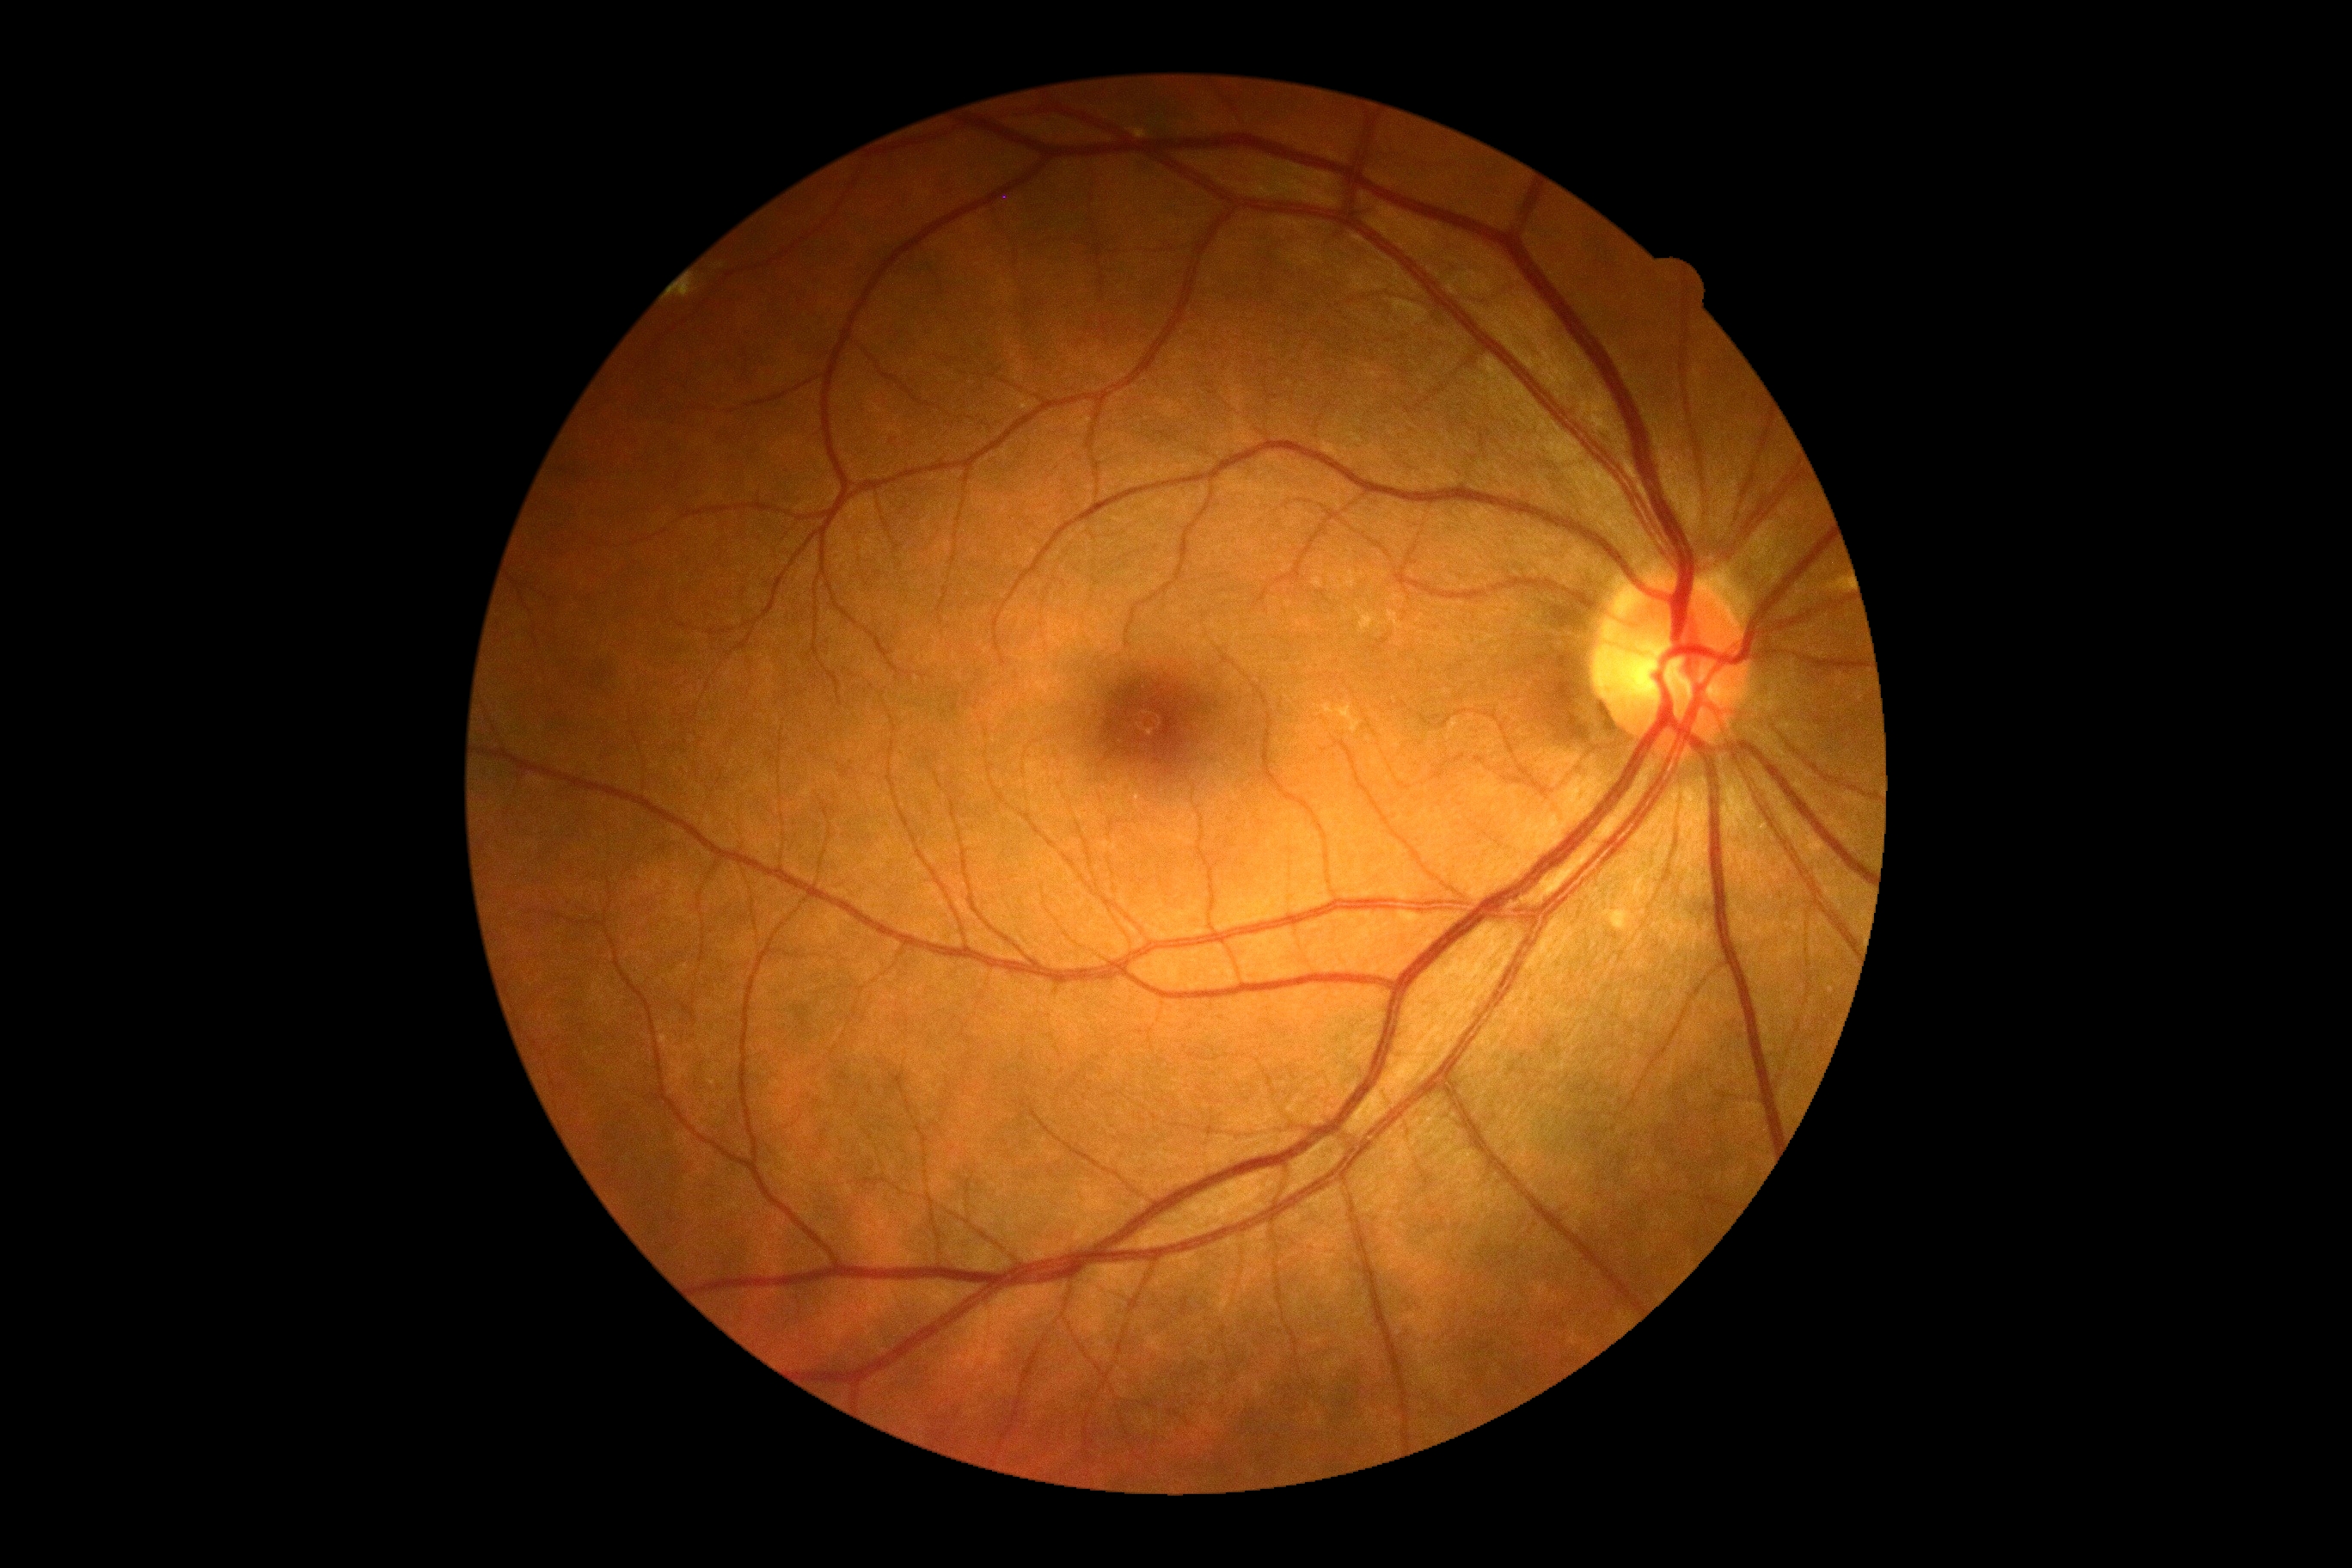

dr_grade: 0/4
dr_impression: no DR findings